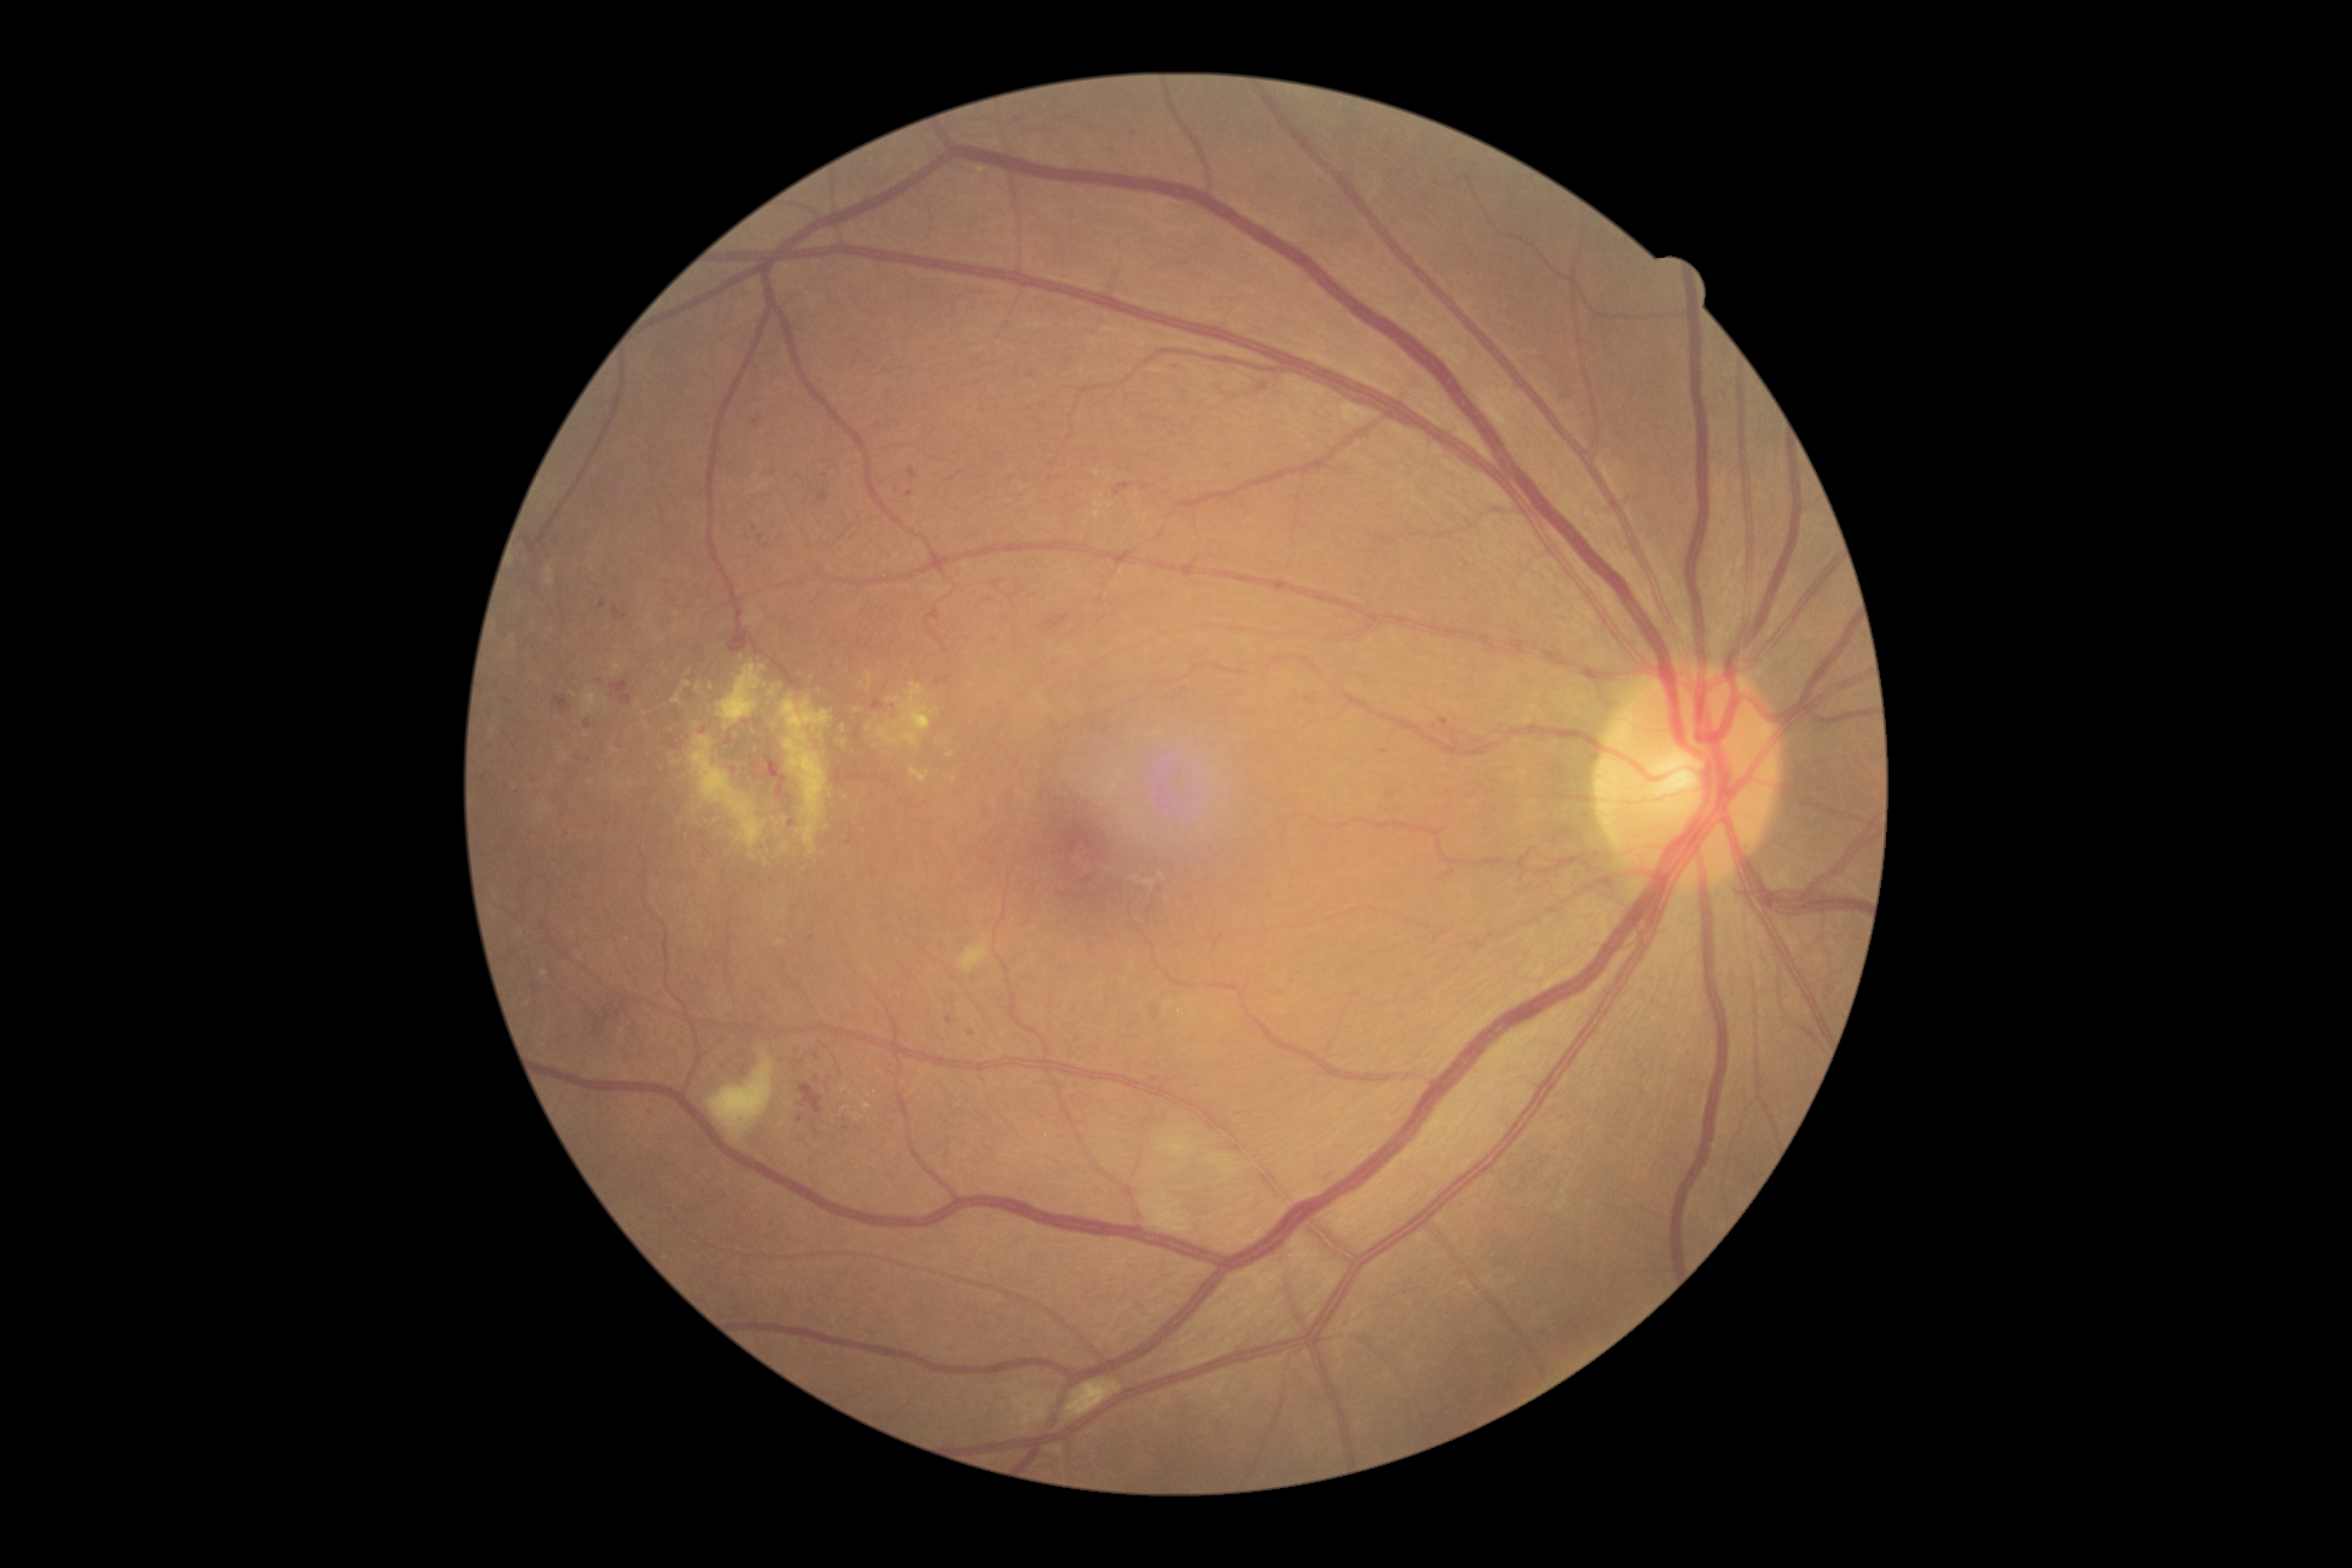 partial: true
dr_grade: 3
dr_grade_name: severe NPDR
lesions:
  se:
    - bbox(1208, 1155, 1244, 1201)
    - bbox(1065, 1379, 1123, 1419)
    - bbox(1142, 1111, 1226, 1242)
    - bbox(958, 941, 990, 972)
    - bbox(707, 1052, 775, 1139)
  he:
    - bbox(834, 771, 843, 785)
    - bbox(592, 998, 621, 1029)
    - bbox(610, 682, 629, 694)
    - bbox(540, 942, 555, 954)
    - bbox(1044, 615, 1069, 631)
    - bbox(555, 695, 572, 714)
    - bbox(613, 607, 627, 620)
    - bbox(751, 762, 762, 770)
    - bbox(762, 756, 787, 797)
    - bbox(1114, 483, 1132, 497)
    - bbox(799, 1082, 823, 1112)
    - bbox(700, 832, 708, 839)
    - bbox(1555, 377, 1583, 403)
    - bbox(854, 730, 860, 740)
    - bbox(872, 700, 884, 710)
    - bbox(729, 627, 750, 653)
  he_small_approx:
    - [707, 851]
    - [813, 1124]
  ma:
    - bbox(620, 695, 632, 705)
    - bbox(797, 1114, 806, 1122)
    - bbox(1439, 718, 1449, 730)
    - bbox(906, 491, 914, 497)
    - bbox(584, 720, 591, 729)
  ma_small_approx:
    - [773, 472]
    - [817, 1078]
    - [996, 640]
    - [756, 422]
    - [755, 777]
    - [1384, 752]
    - [811, 938]
    - [765, 546]
    - [704, 730]
    - [825, 476]
    - [846, 1128]
    - [565, 832]
    - [507, 701]
    - [675, 745]
    - [602, 605]
  ex:
    - bbox(779, 694, 833, 854)
    - bbox(769, 687, 777, 696)
    - bbox(840, 1106, 850, 1112)
    - bbox(1079, 503, 1138, 539)
    - bbox(672, 694, 683, 705)
    - bbox(695, 685, 701, 693)
    - bbox(841, 1082, 849, 1092)
    - bbox(863, 672, 873, 691)
    - bbox(877, 683, 938, 748)
  ex_small_approx:
    - [852, 1092]
    - [951, 754]
    - [697, 725]
    - [828, 828]
    - [861, 683]
    - [858, 1096]
    - [780, 685]
    - [869, 729]